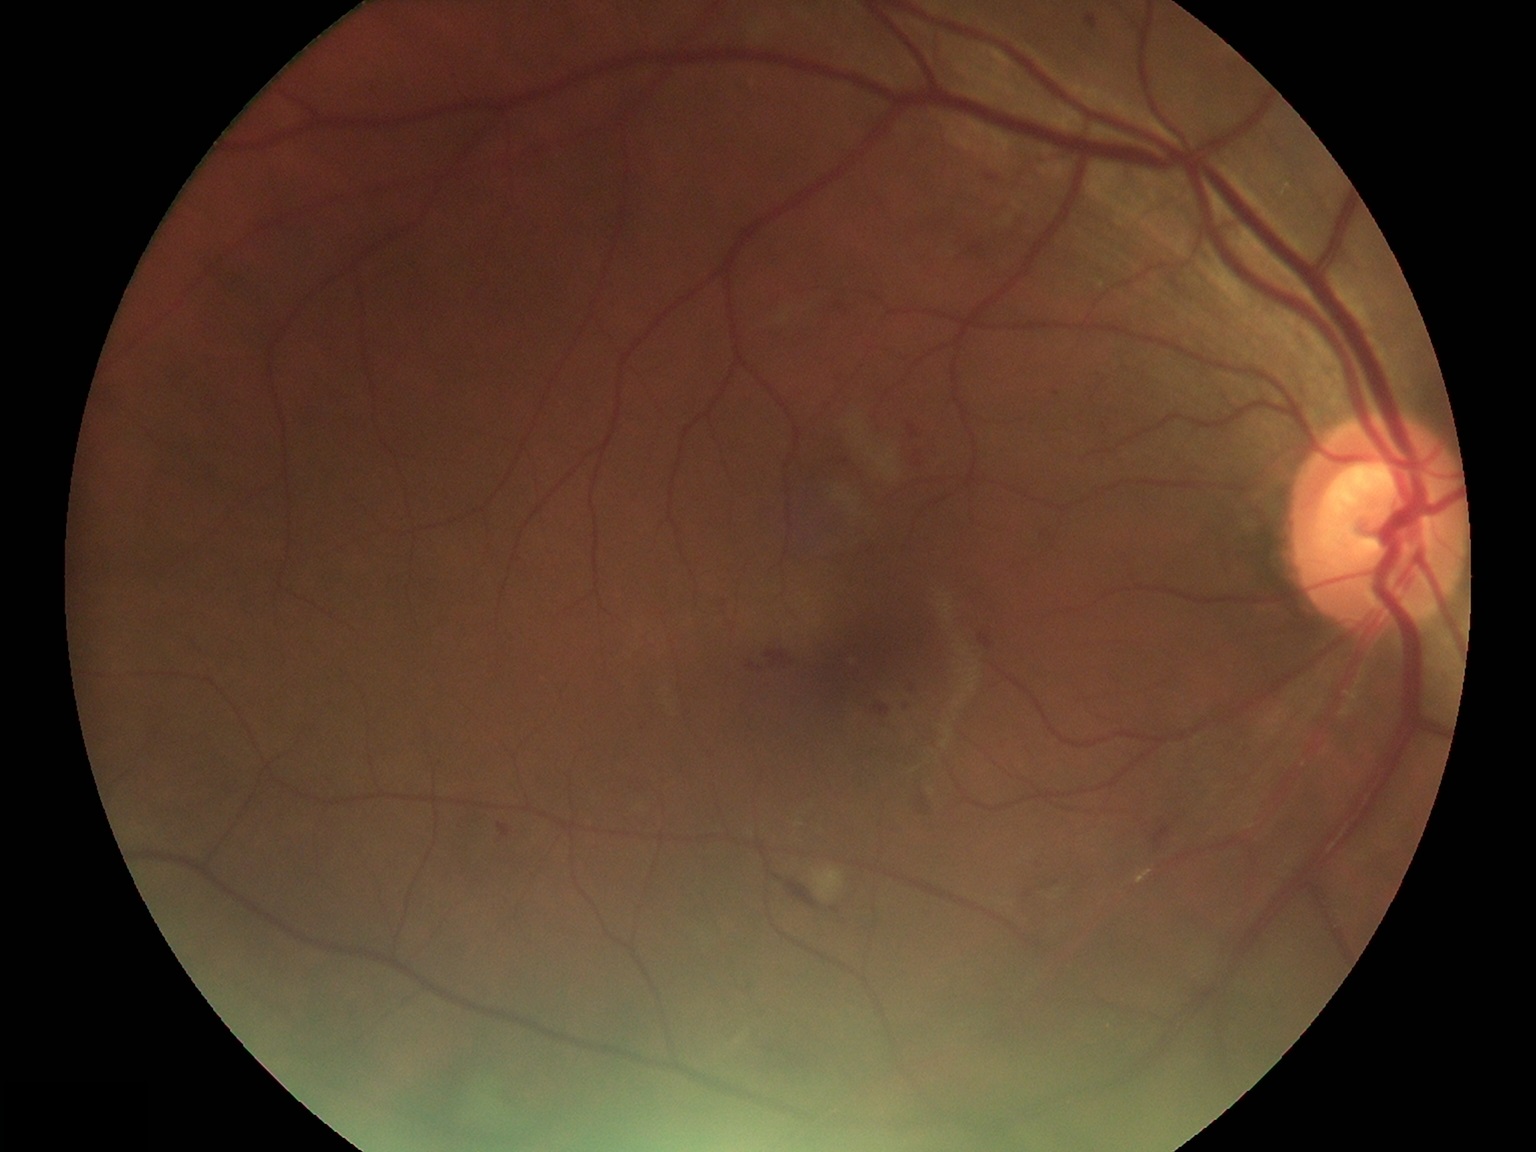
Diabetic retinopathy (DR) is grade 2 (moderate NPDR). Disease class: non-proliferative diabetic retinopathy.